Retinal fundus photograph.
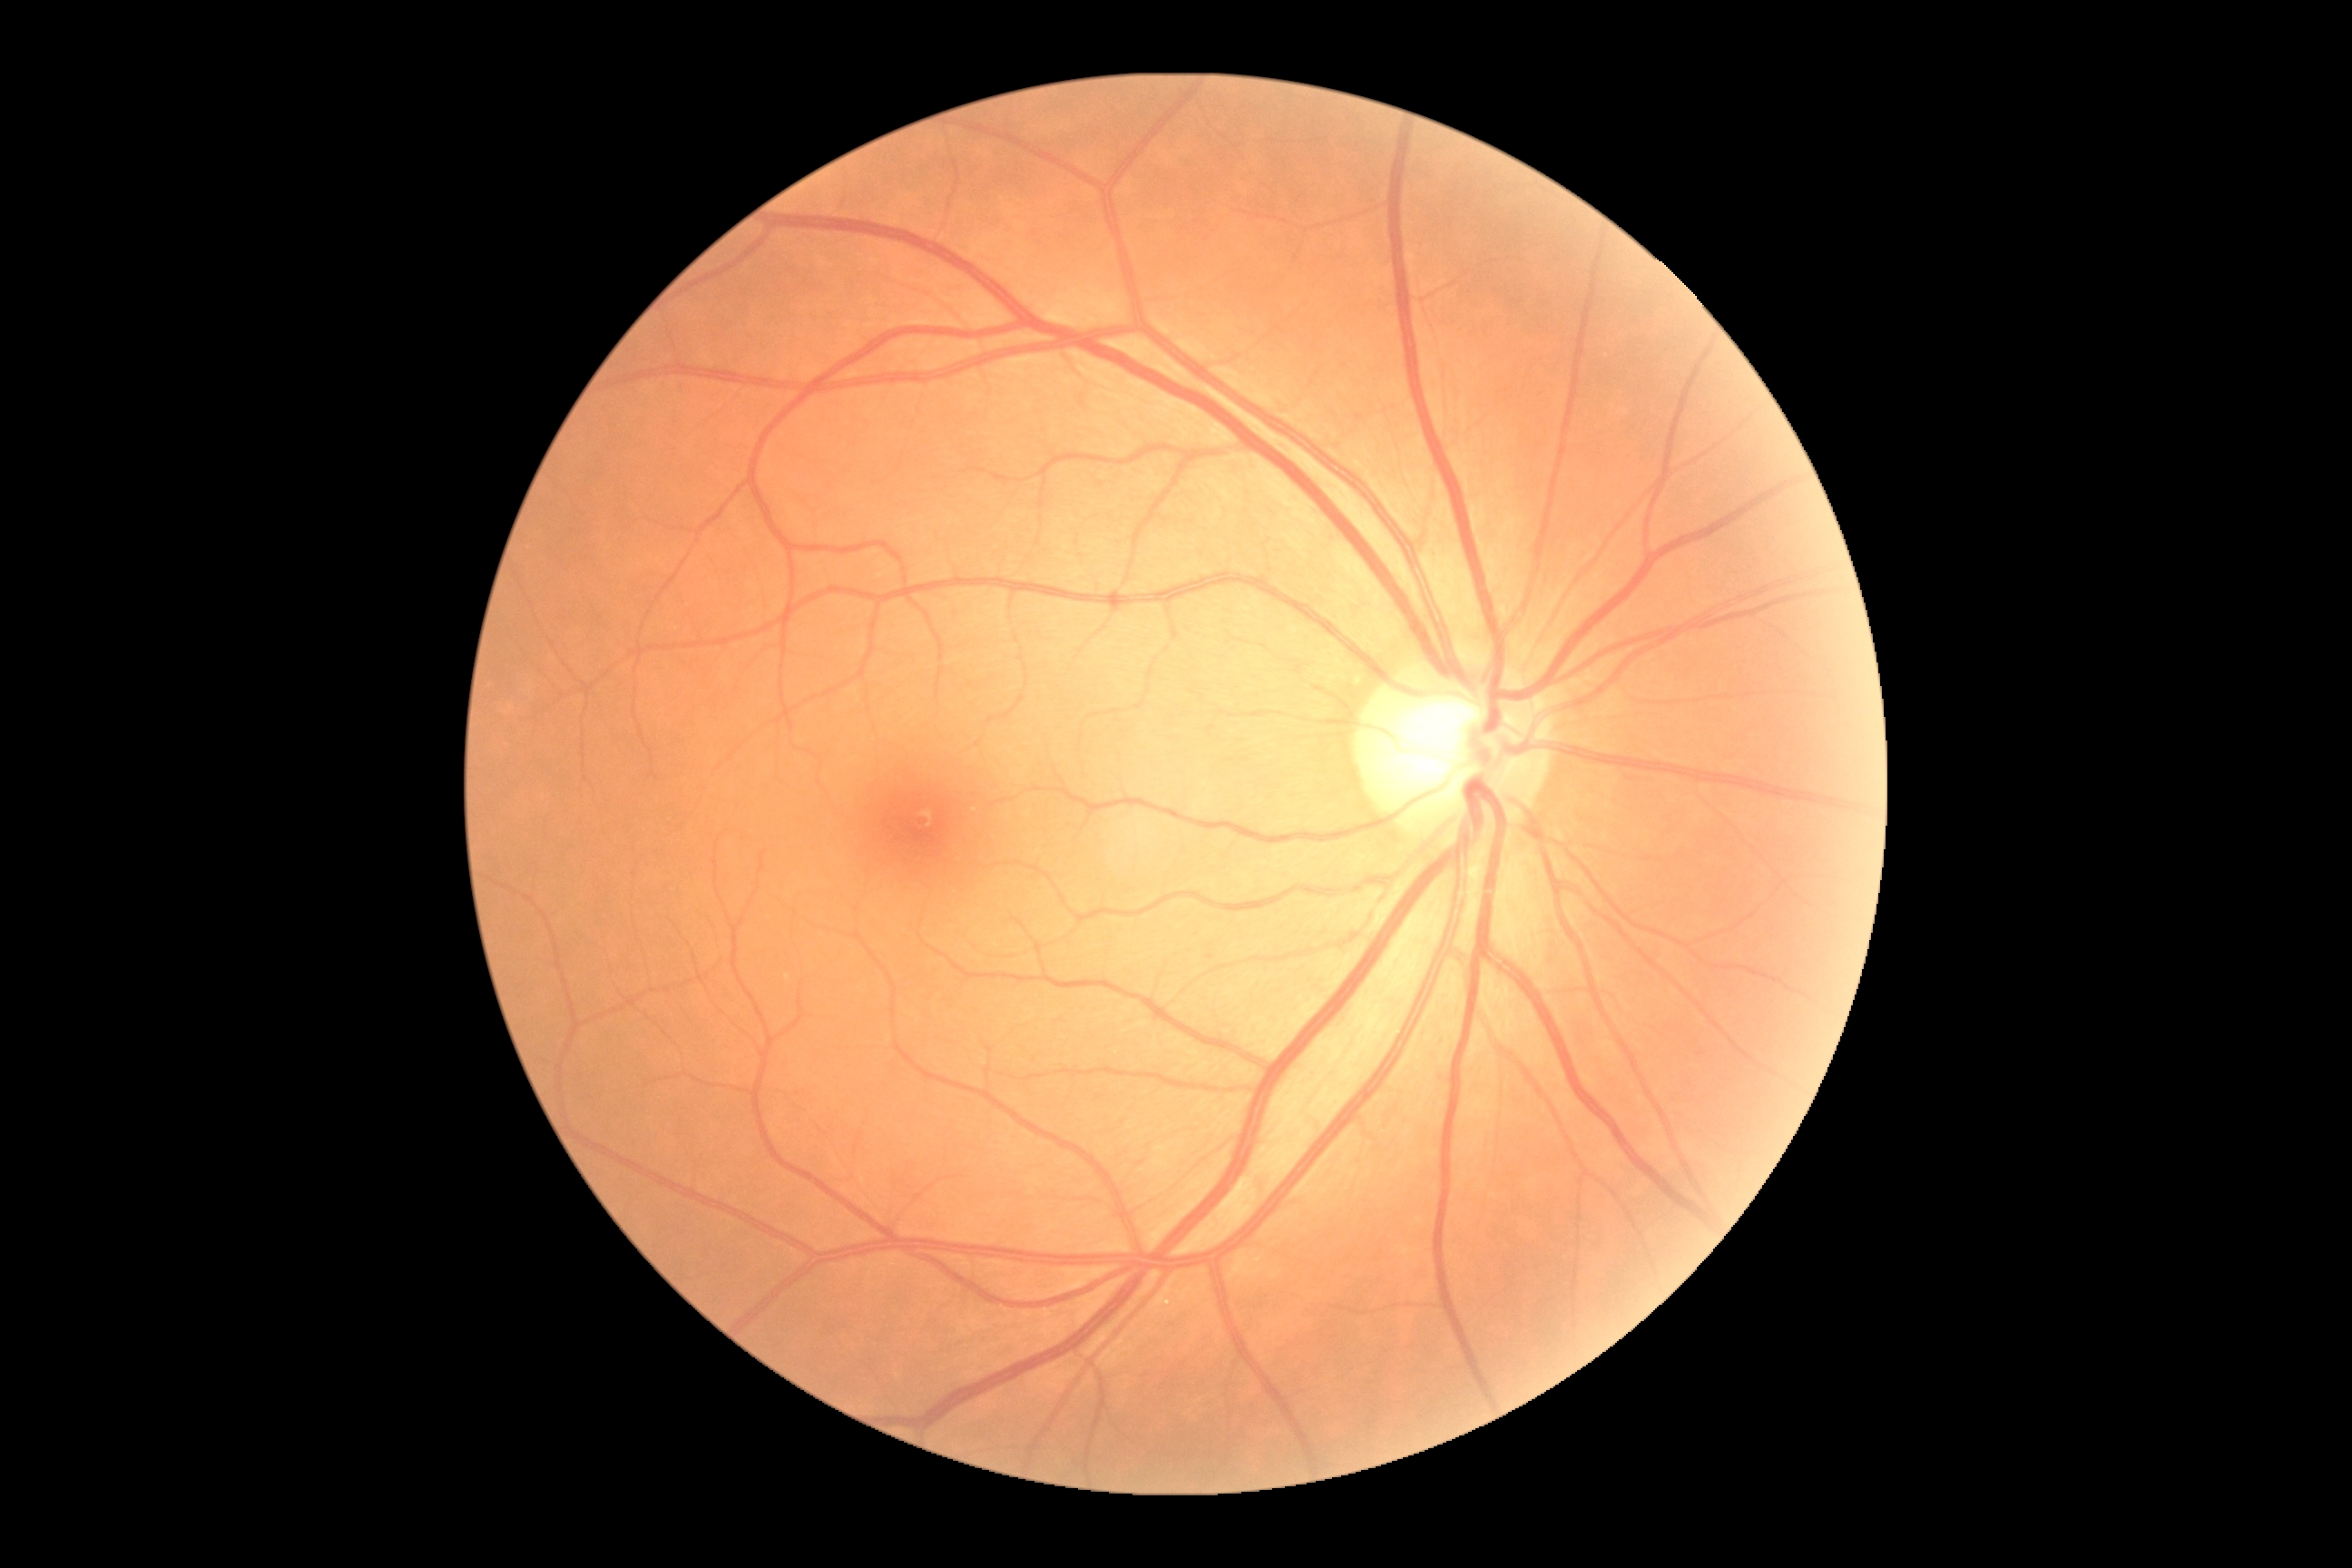
dr_grade: no apparent retinopathy (grade 0)
dr_impression: no signs of DR